Portable fundus photograph. 60-degree field of view — 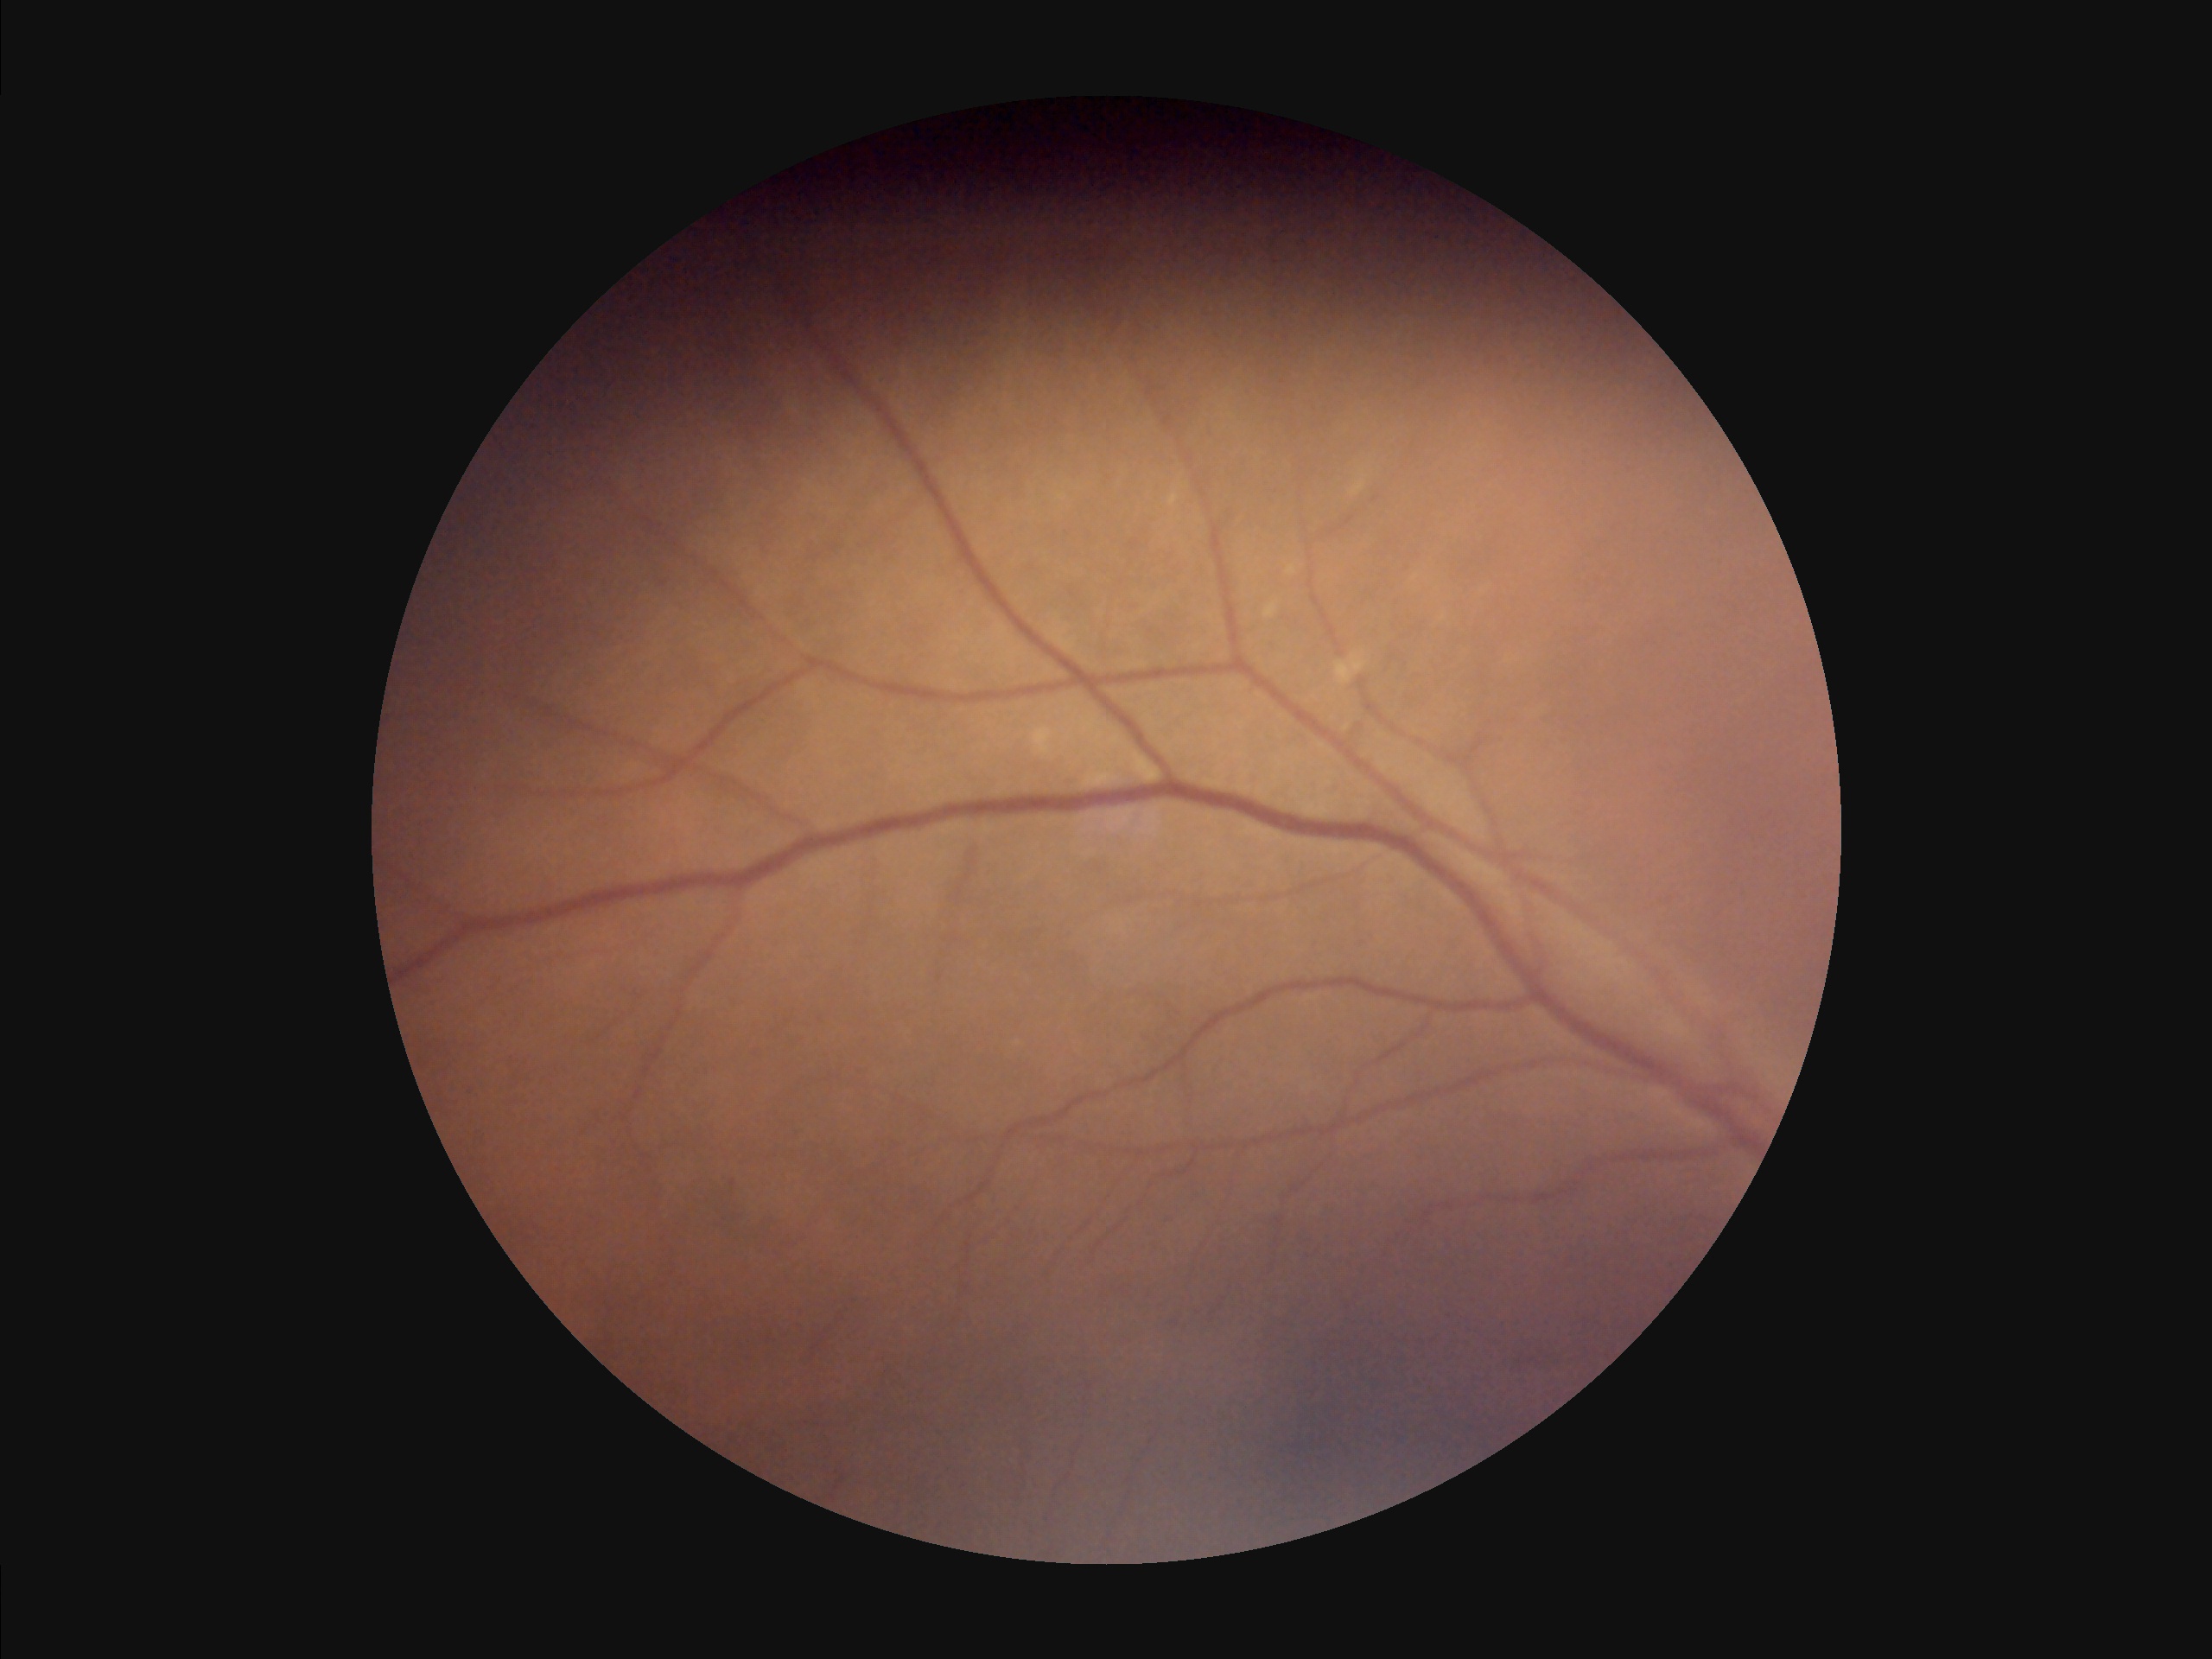
No noticeable blur. Image quality is suboptimal. There is over- or under-exposure or a color cast. Vessels and details are hard to distinguish.